Captured after pupil dilation · FOV: 50 degrees
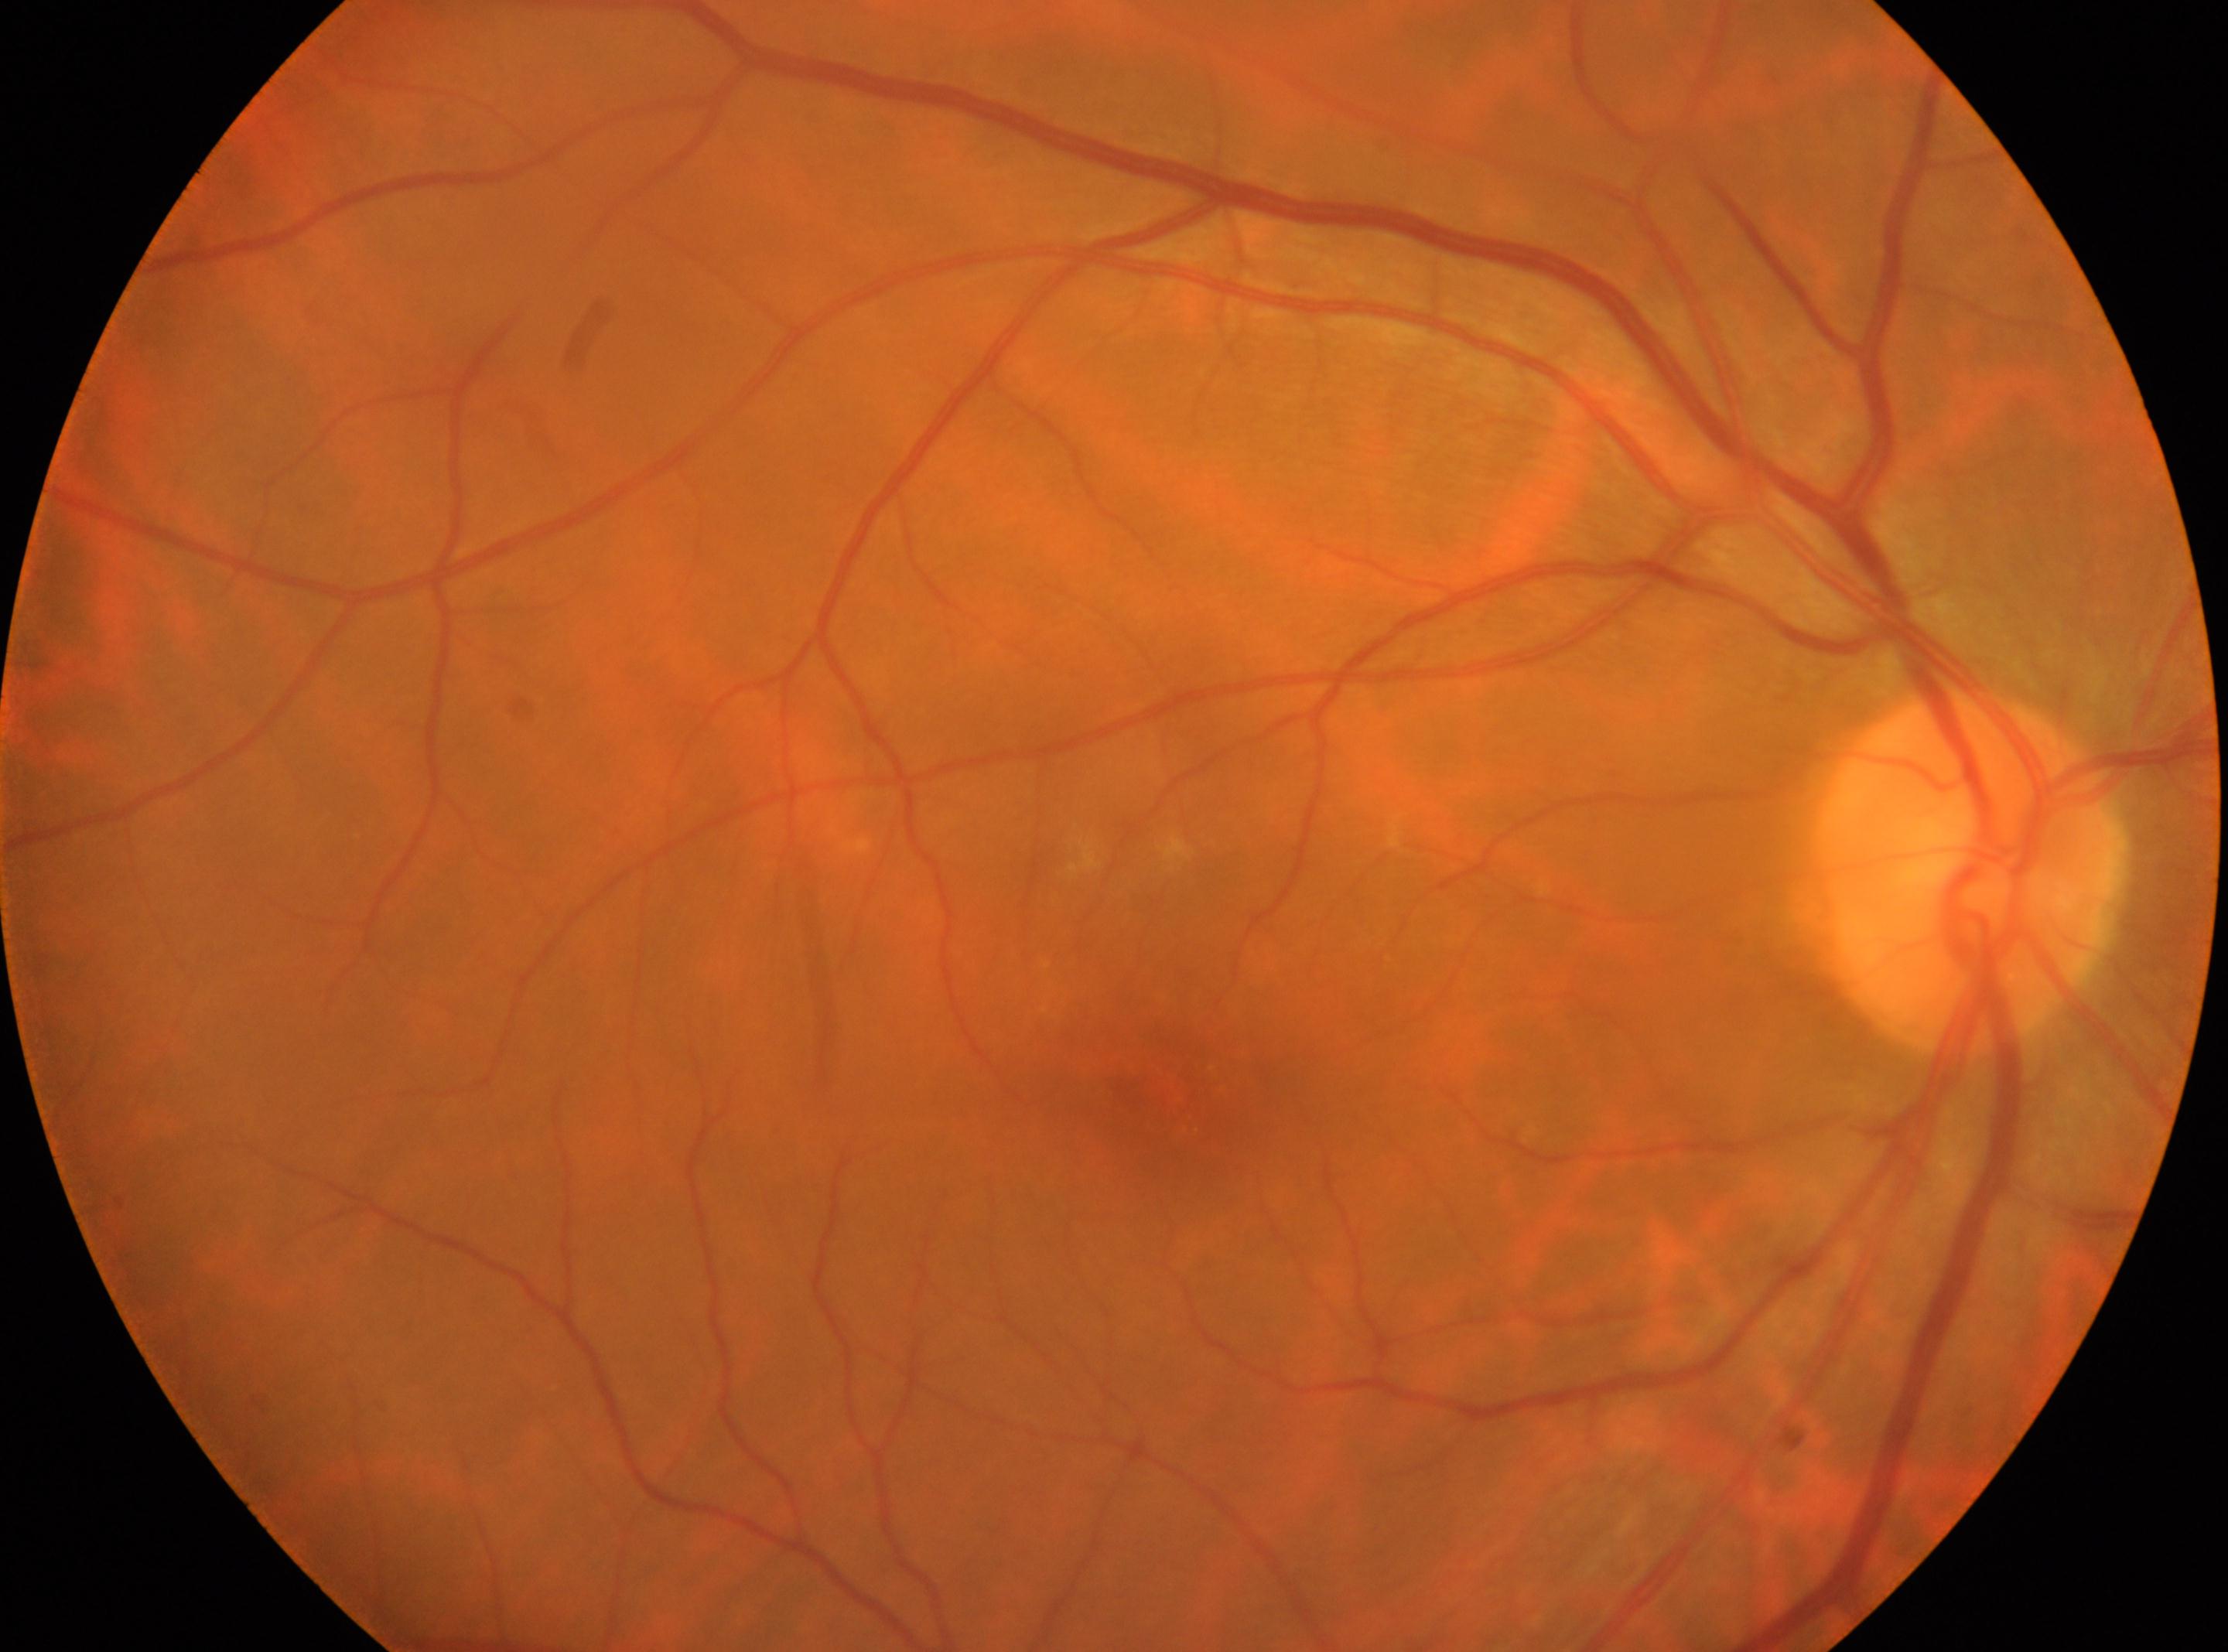
Optic nerve head located at 1966px, 875px. Fovea center located at 1171px, 1092px. Eye: right. Retinopathy grade: 0/4.